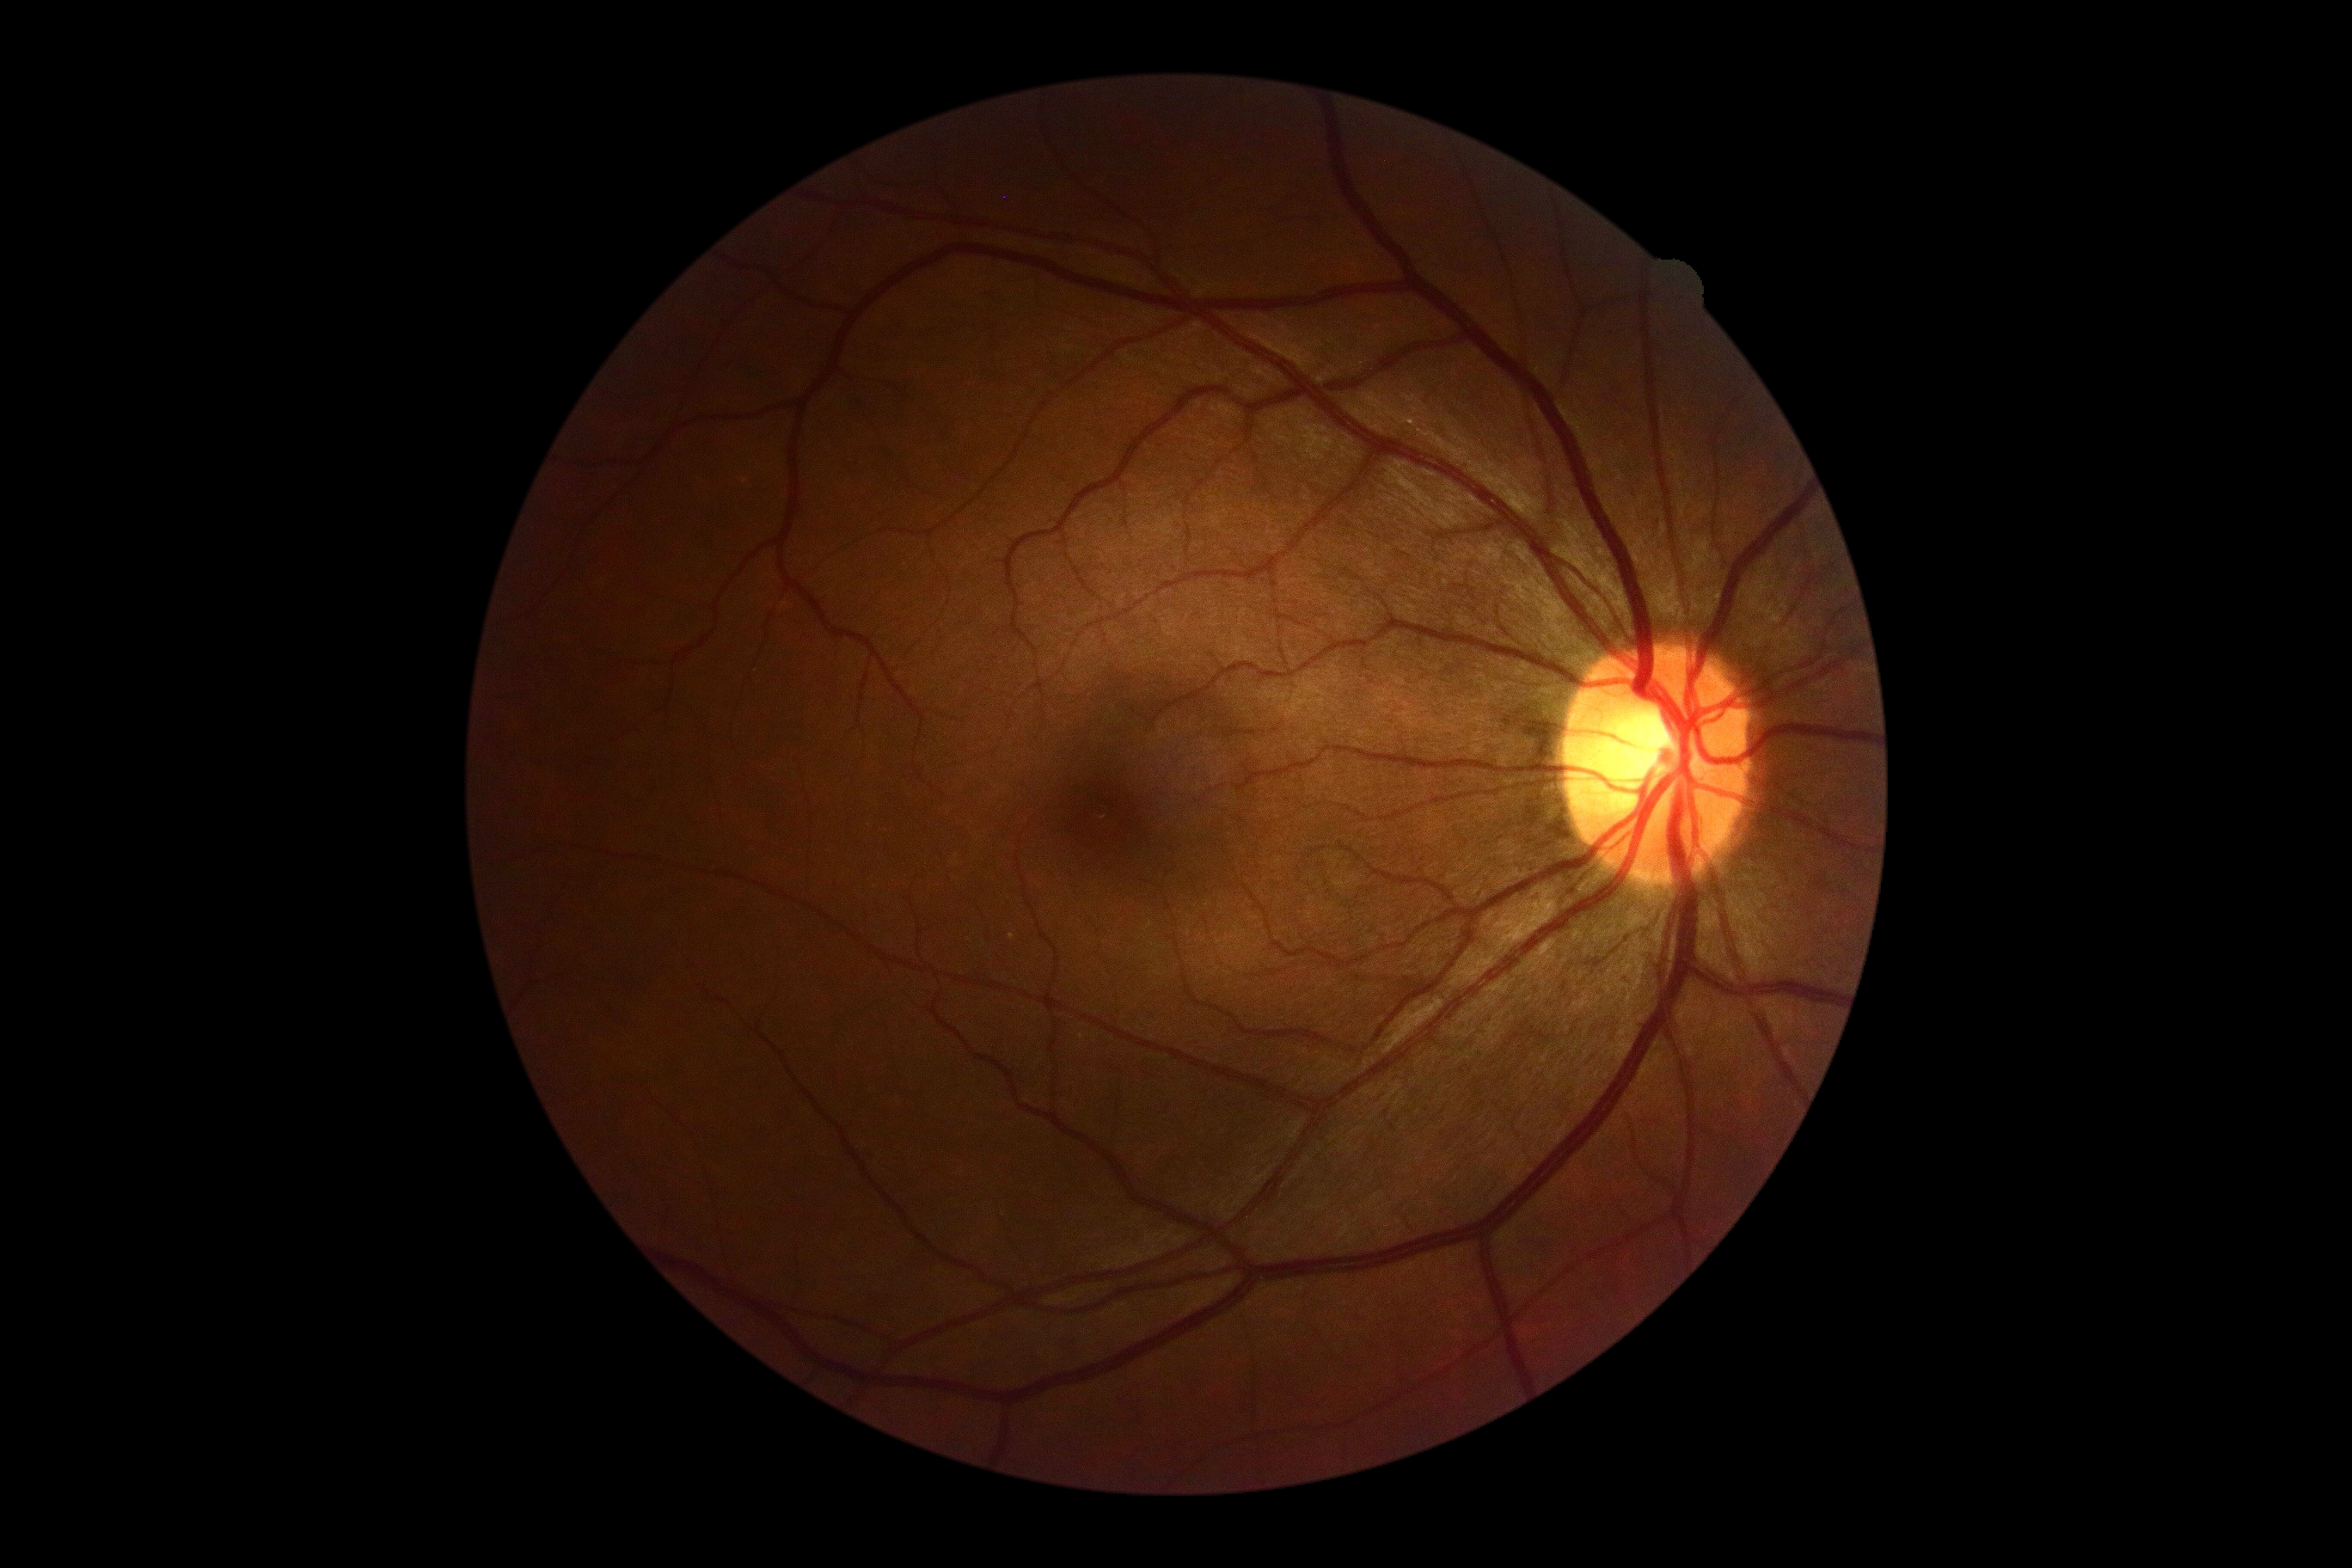
{"dr_impression": "negative for DR", "dr_grade": "grade 0"}